Color fundus image, camera: Remidio FOP fundus camera — 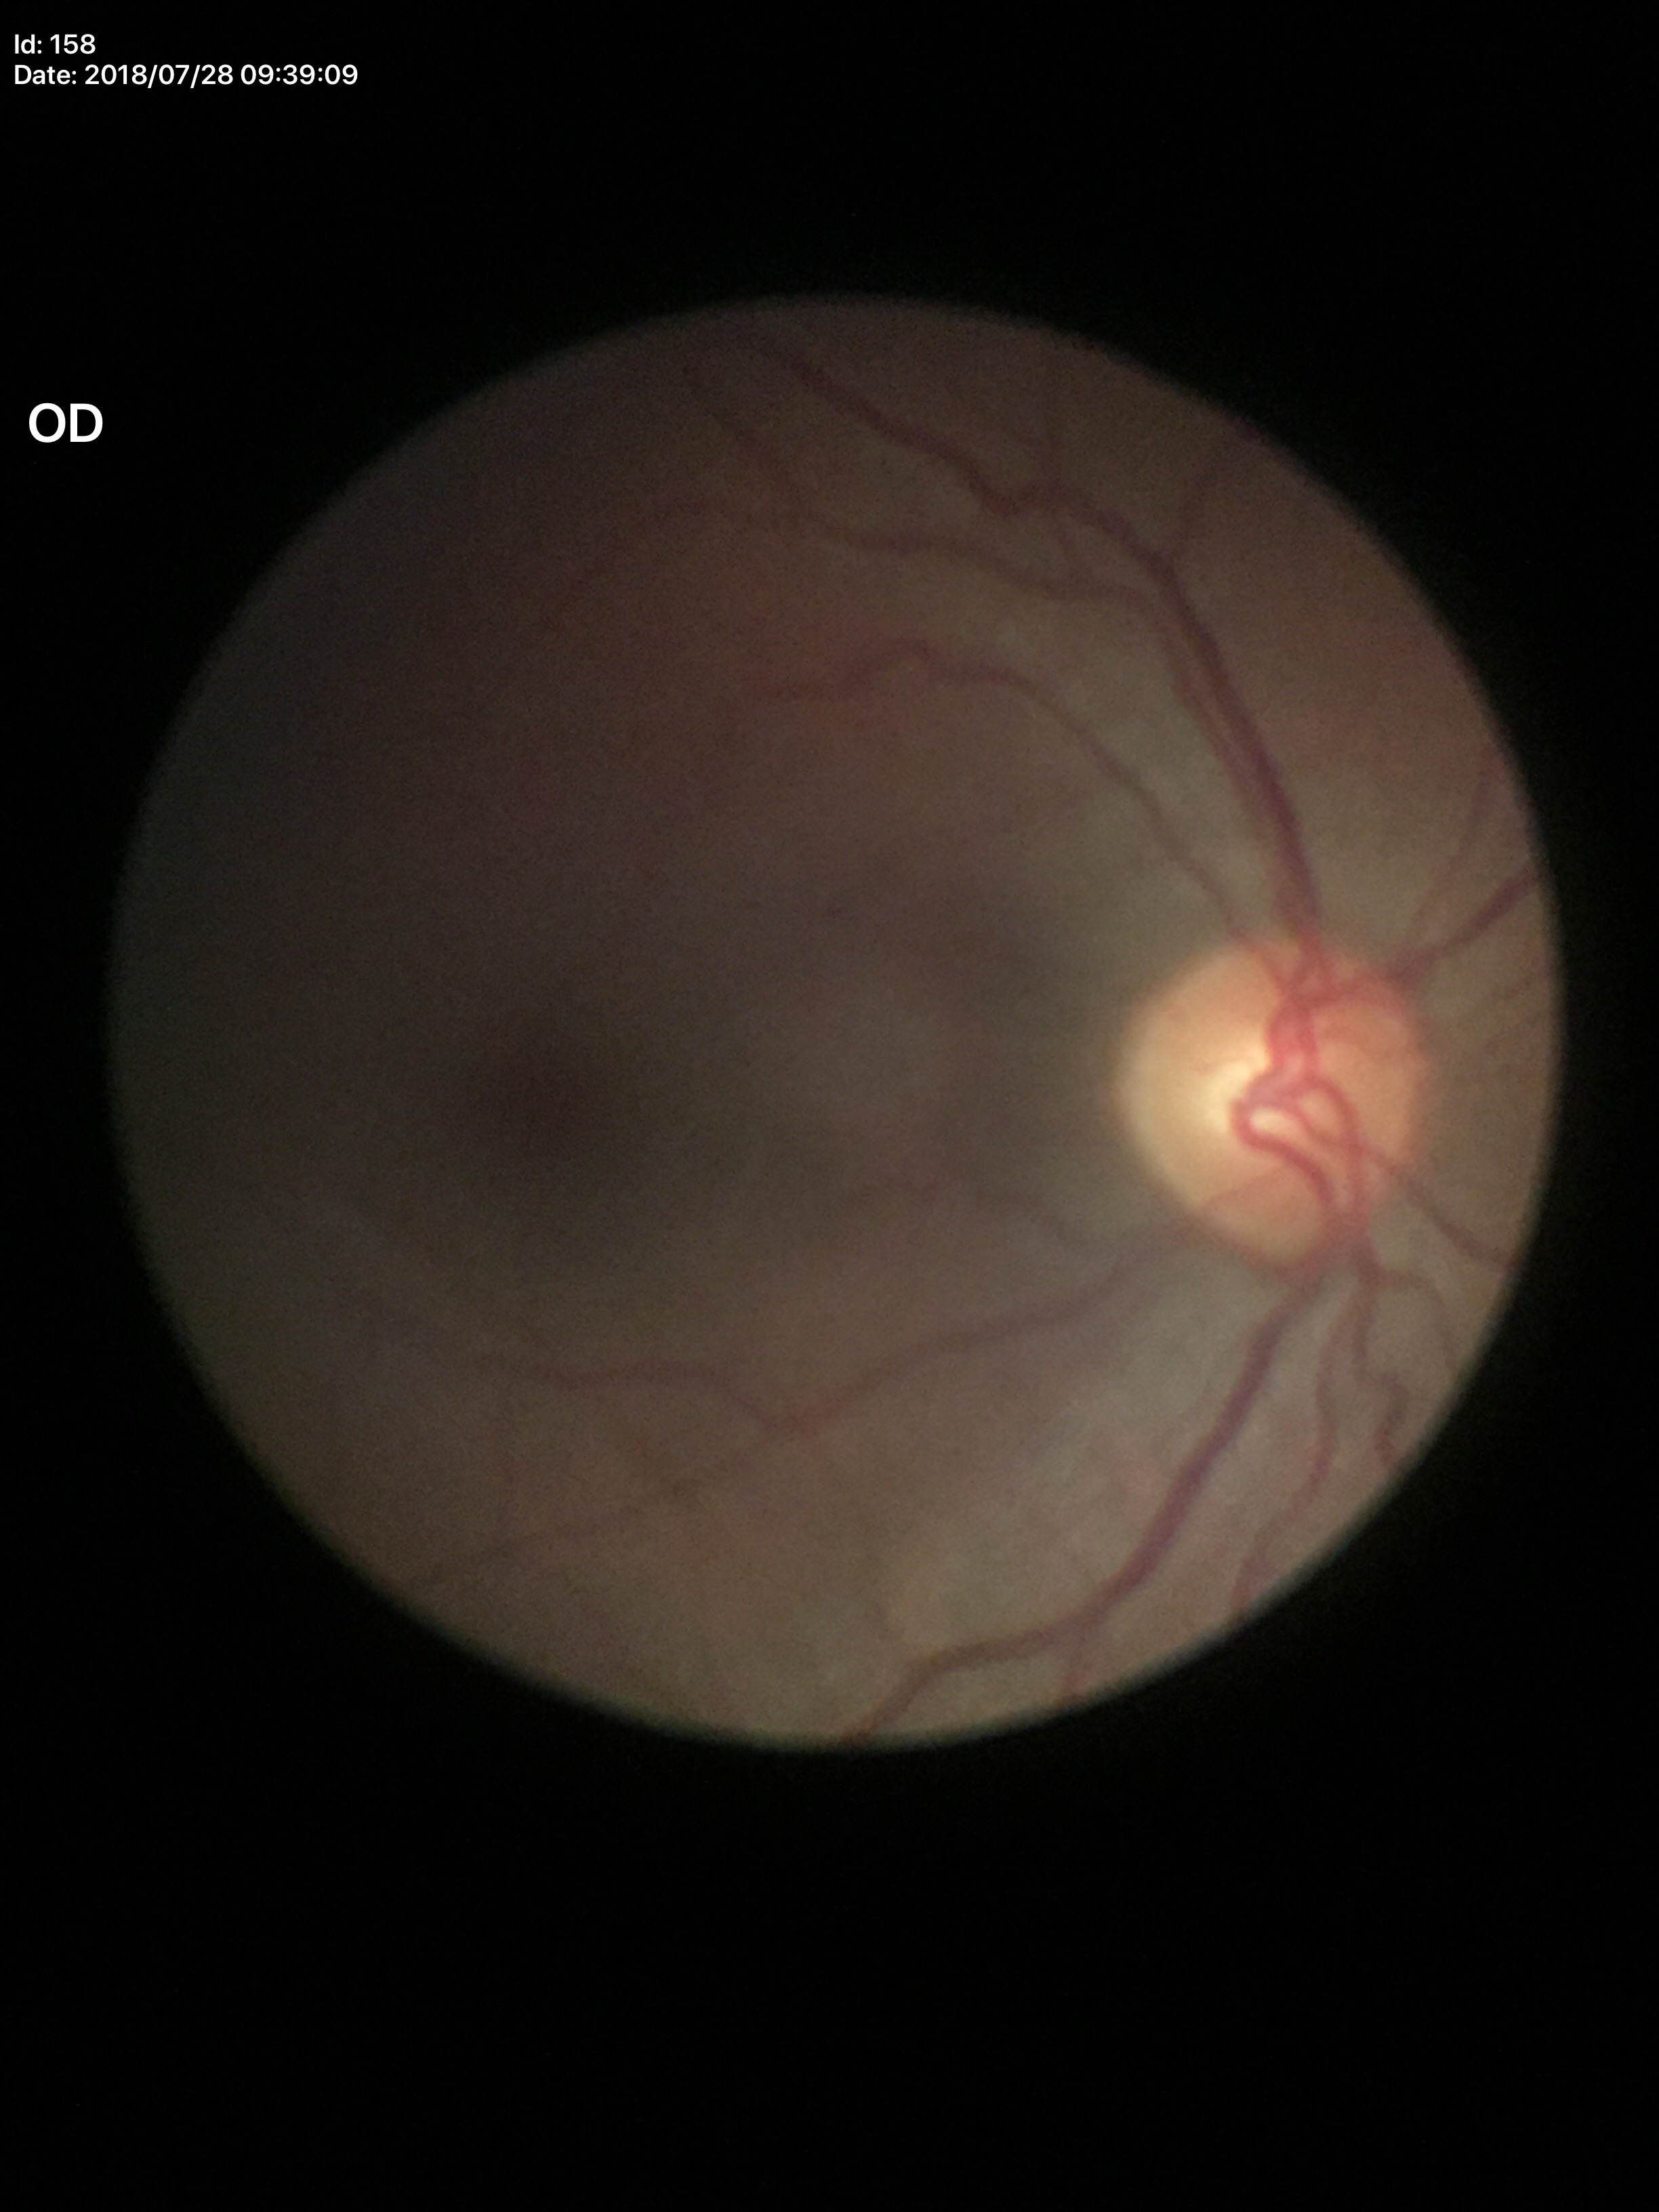
Horizontal cup-disc ratio (HCDR): 0.52. Vertical cup-to-disc ratio (VCDR) of 0.52. Glaucoma decision: negative (2 of 5 graders flagged glaucoma suspect). Area cup-to-disc ratio (ACDR) is 0.27.